45-degree field of view.
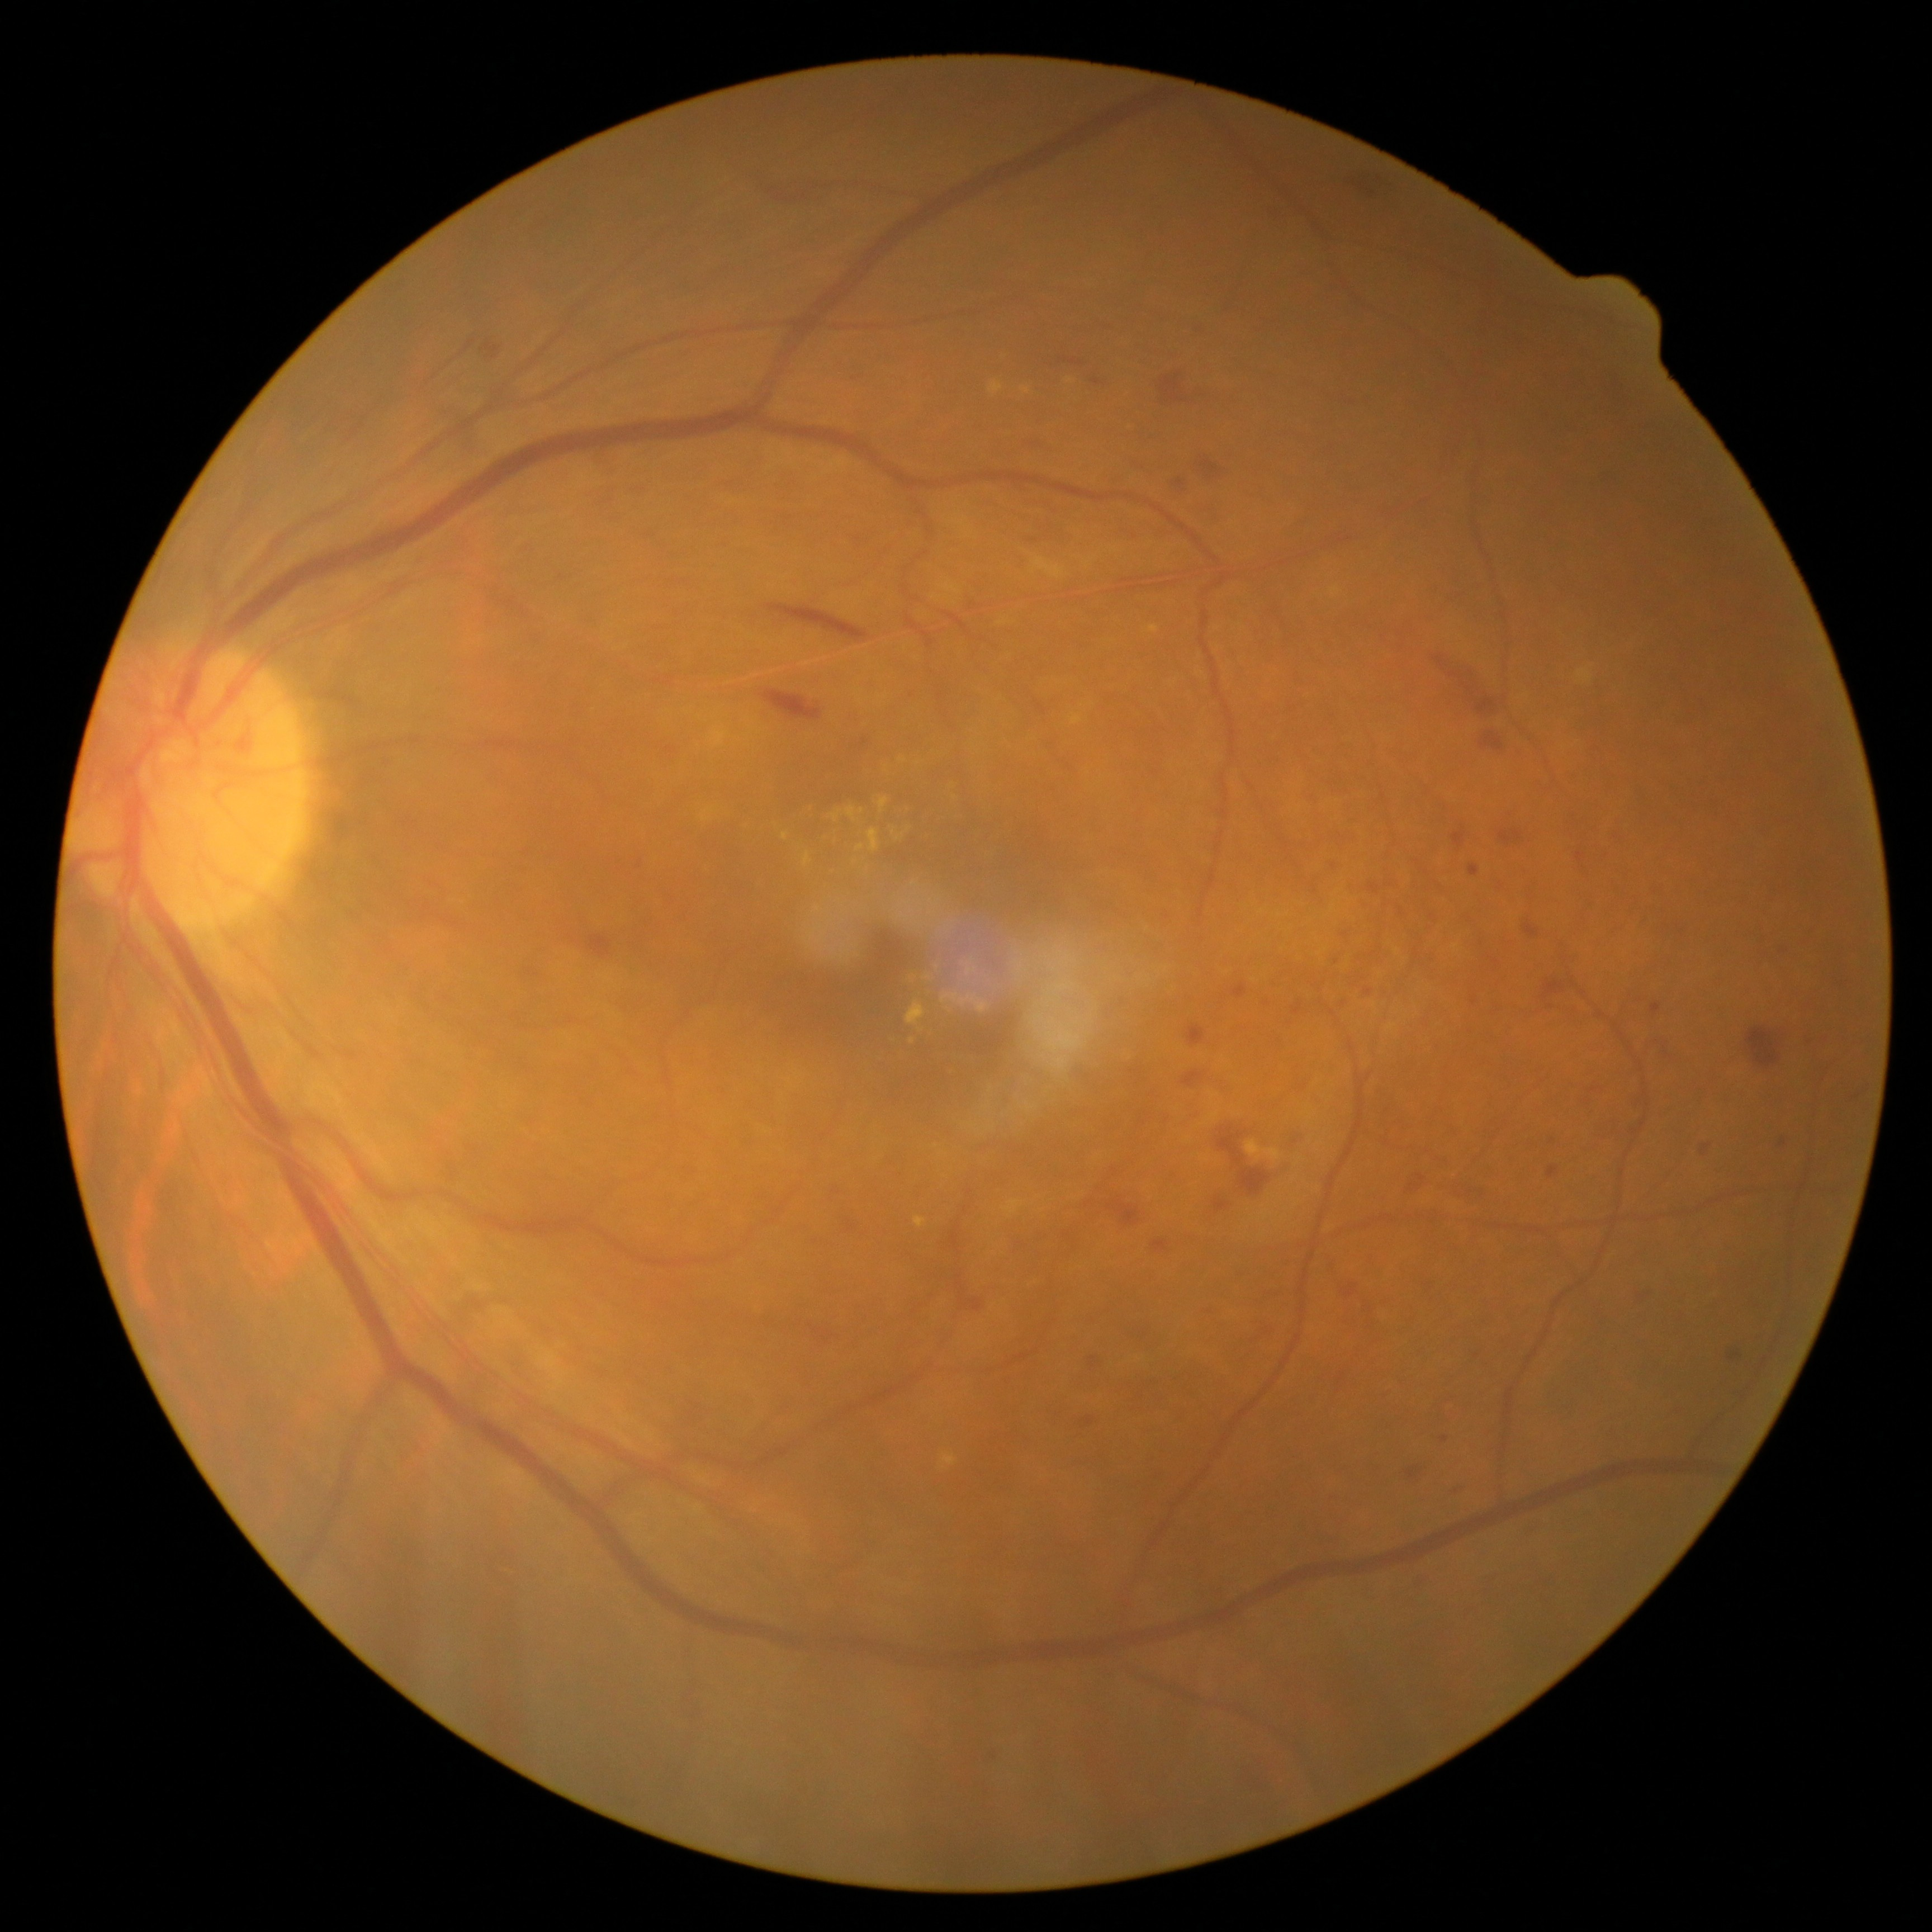 diabetic retinopathy: moderate non-proliferative diabetic retinopathy (grade 2) — more than just microaneurysms but less than severe NPDR.